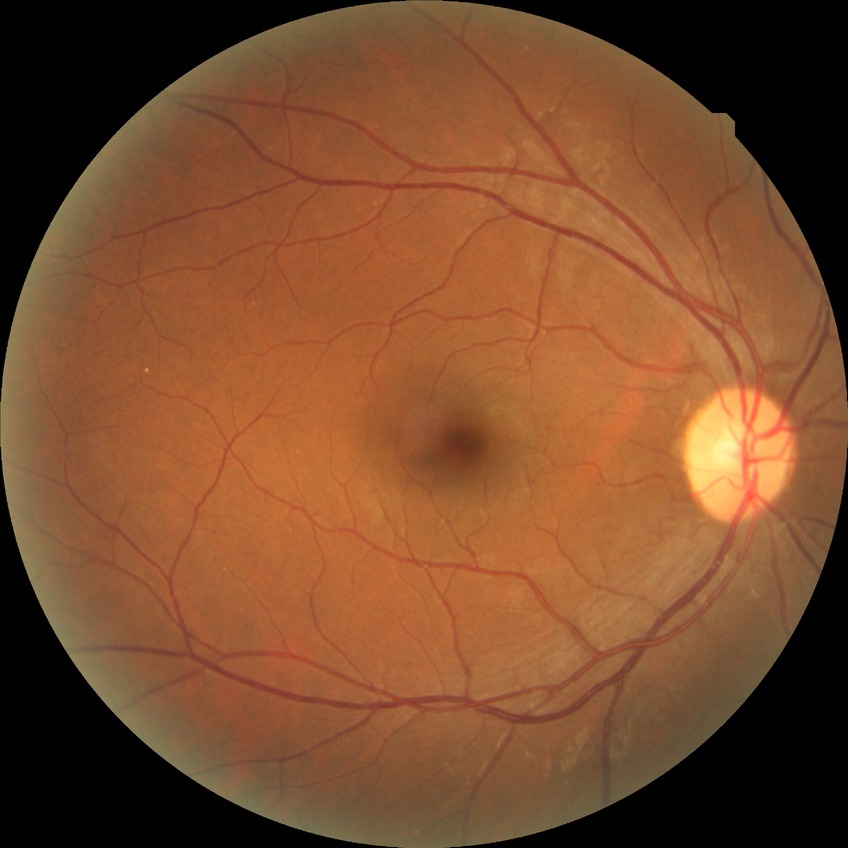

Davis grading=no diabetic retinopathy.